100° field of view (Phoenix ICON). Infant wide-field retinal image
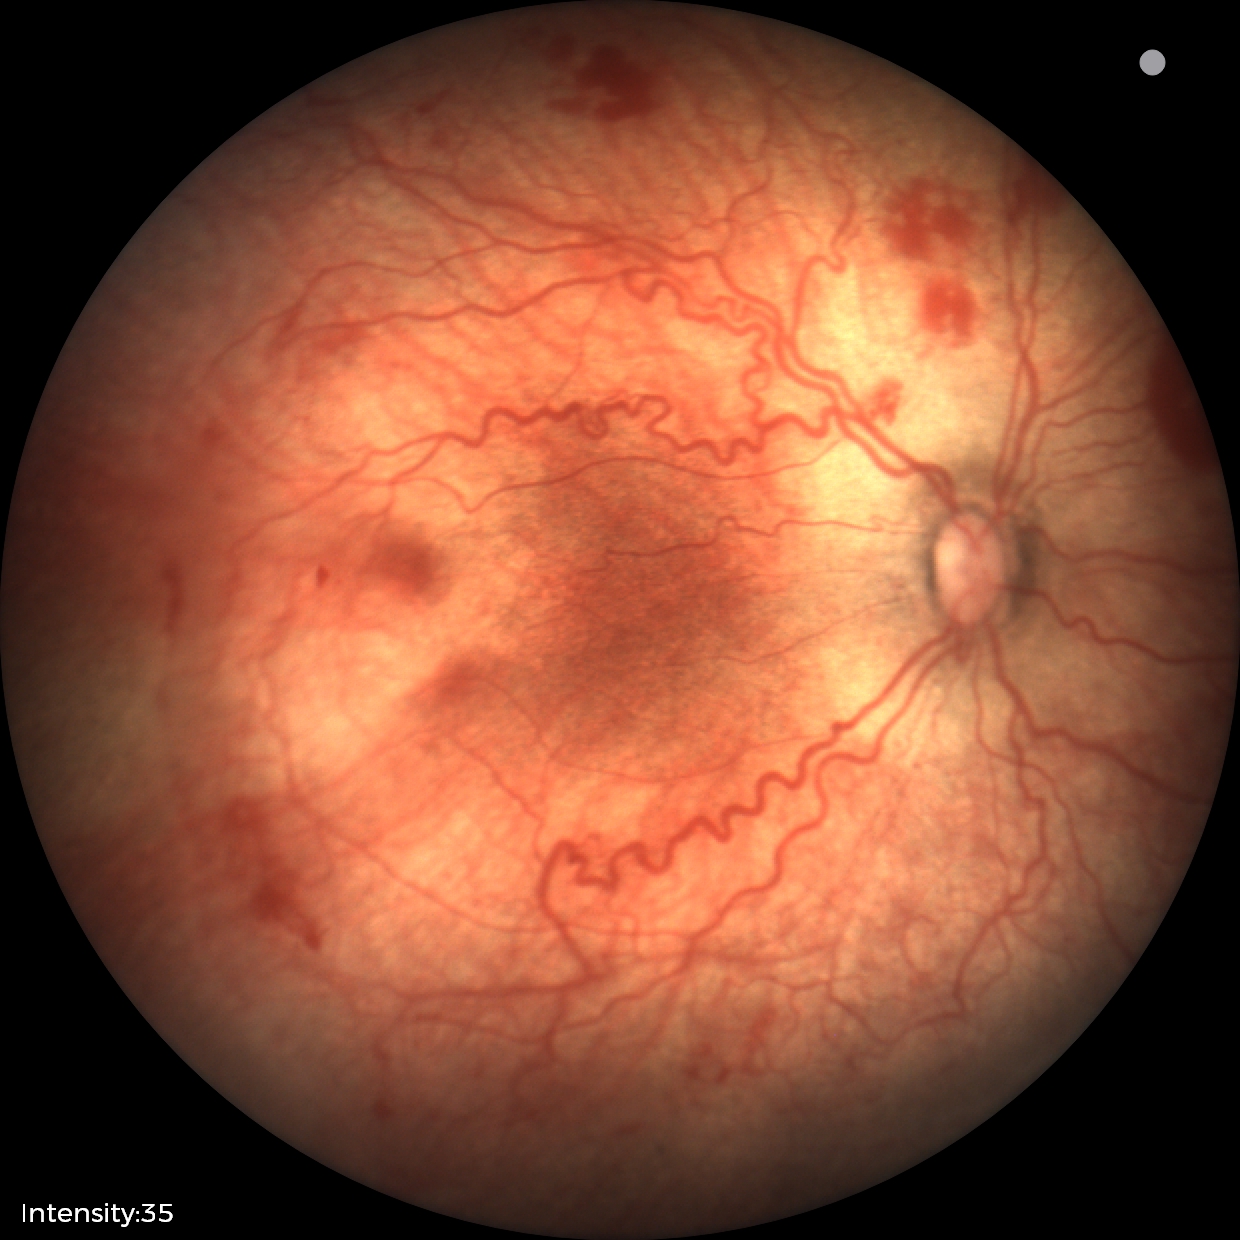
Series diagnosed as ROP stage 2 — ridge with height and width at the demarcation line.